2048 x 1536 pixels. 45° field of view:
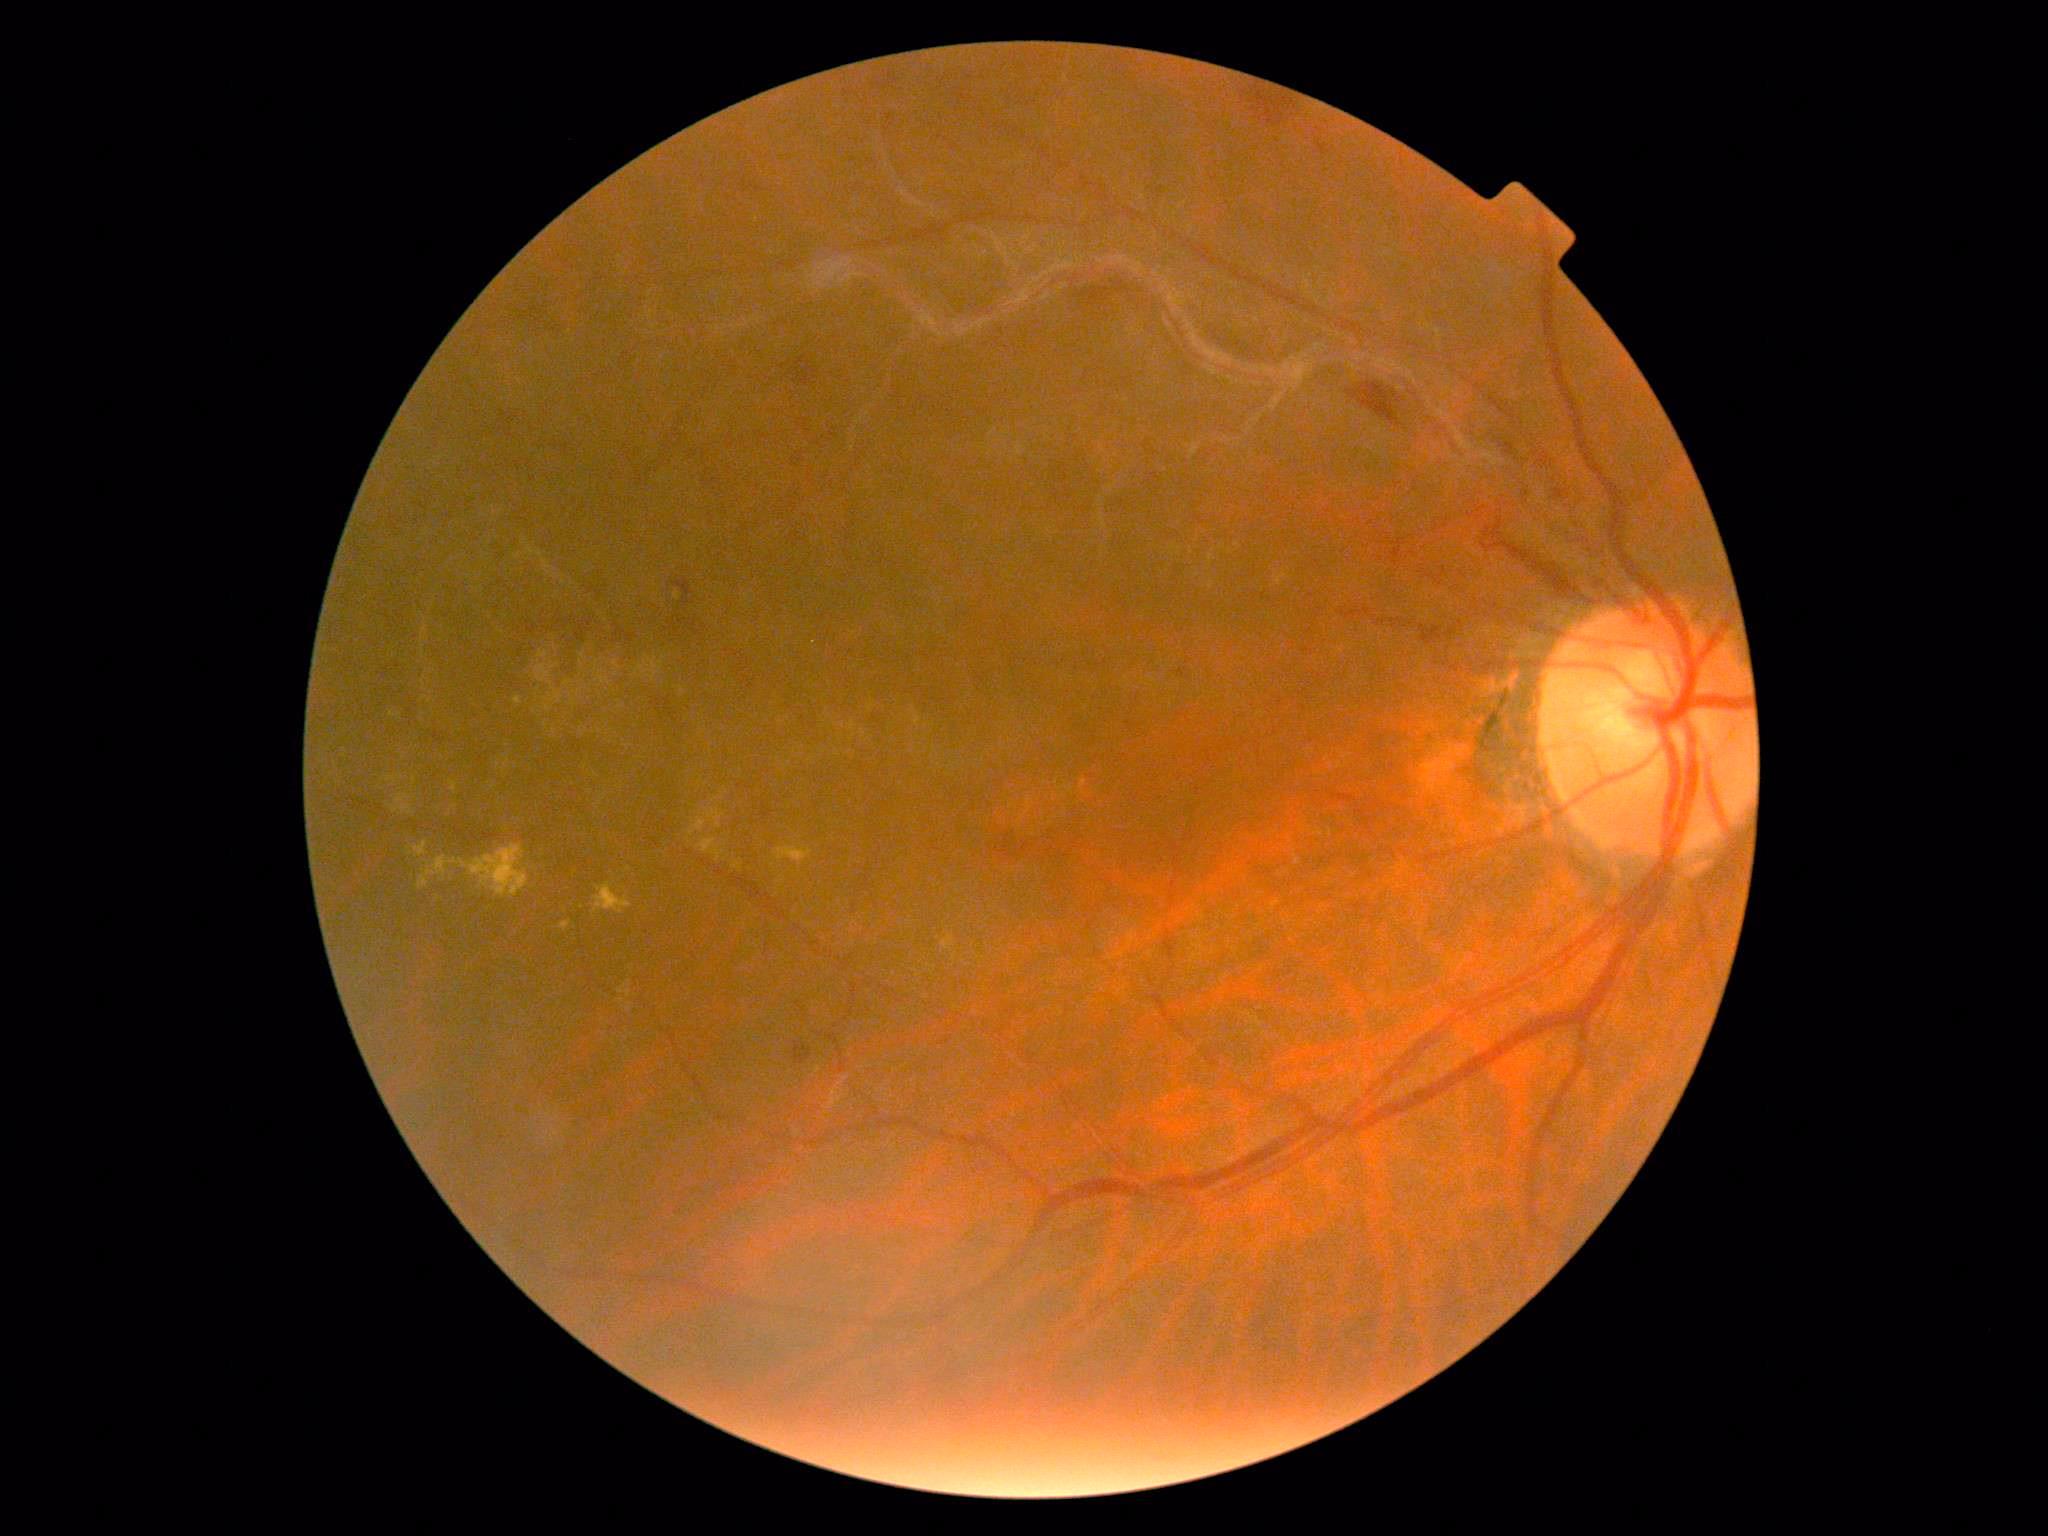

DR stage: grade 2 (moderate NPDR).